100° field of view (Phoenix ICON); pediatric retinal photograph (wide-field):
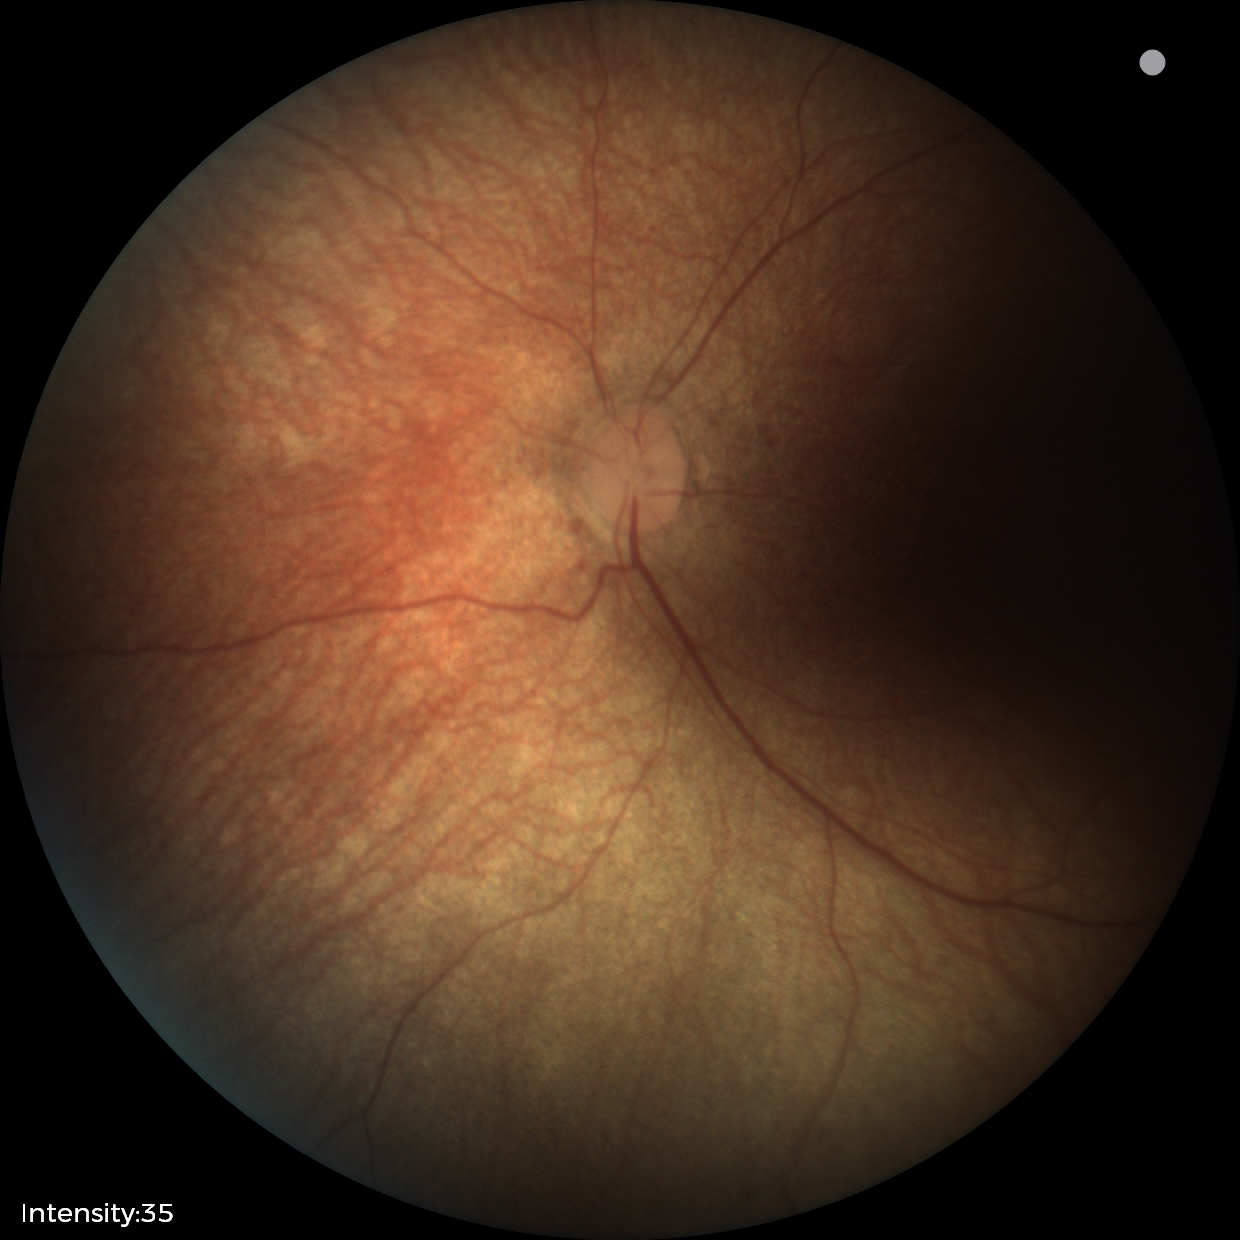
Impression = no pathology identified.